Portable fundus camera image. 2212 by 1659 pixels: 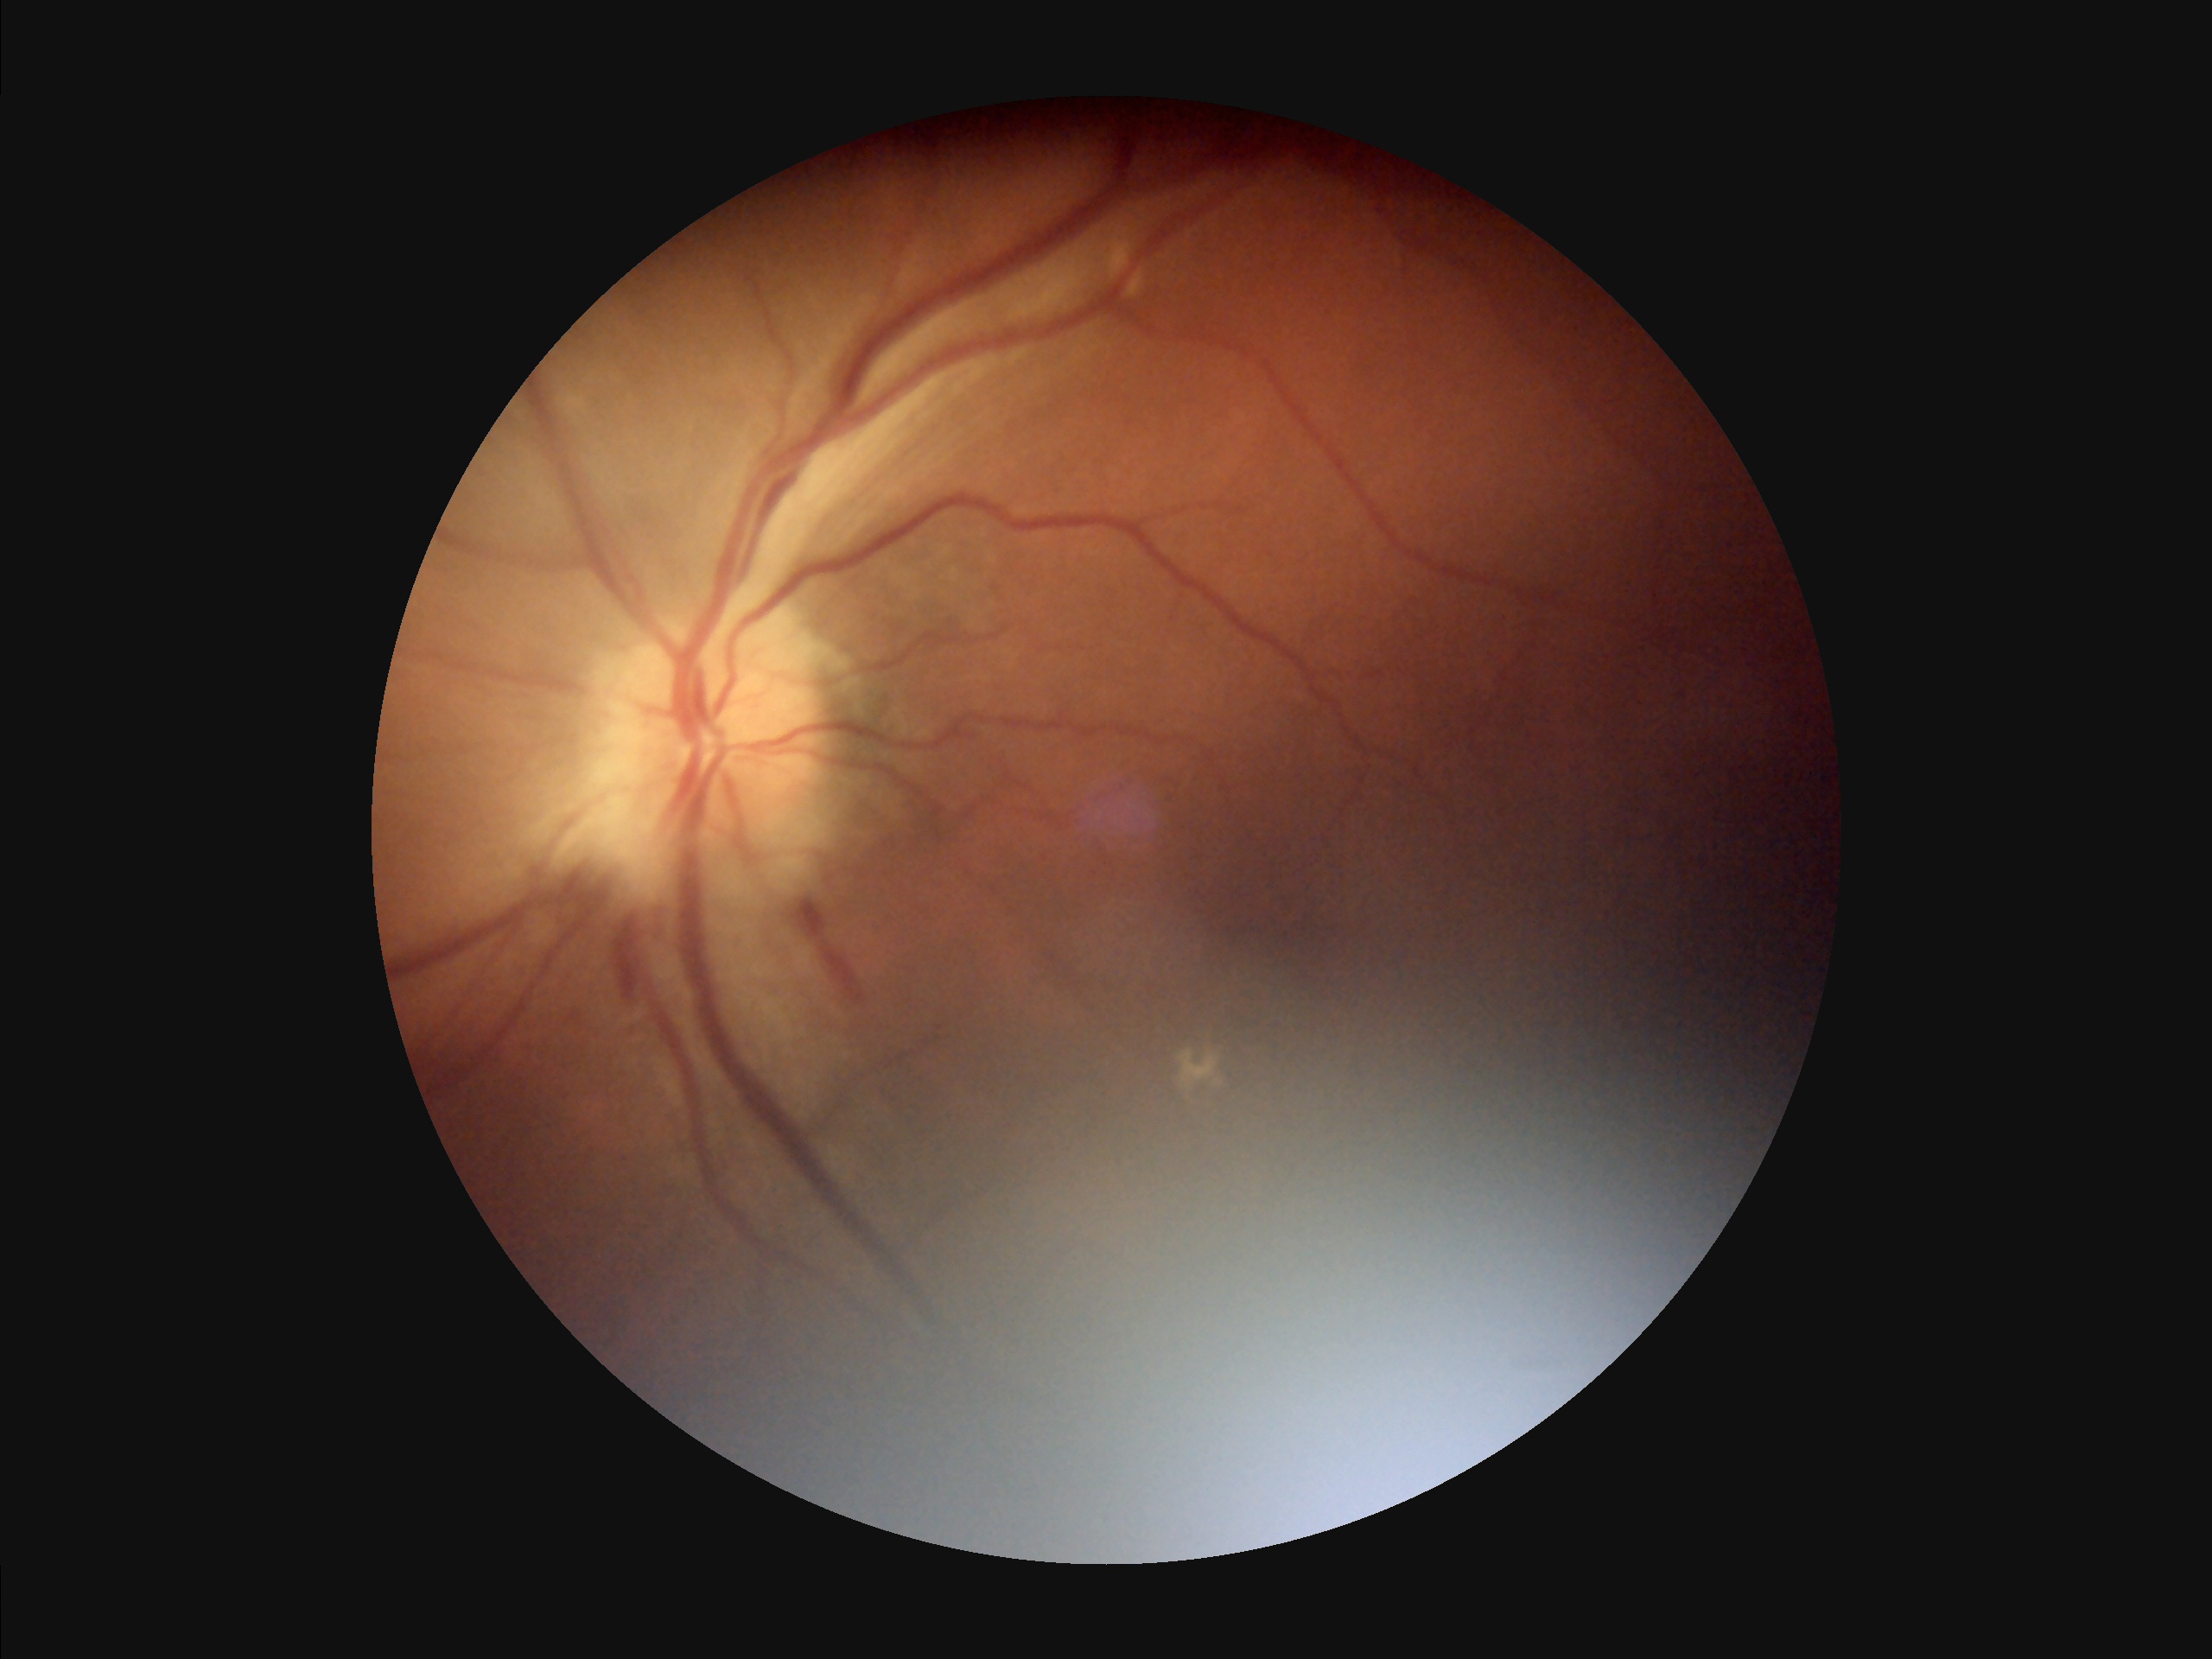 Illumination/color: uneven | Overall: poor | Clarity: poor.